Nonmydriatic fundus photograph; 848x848; 45° field of view; camera: NIDEK AFC-230:
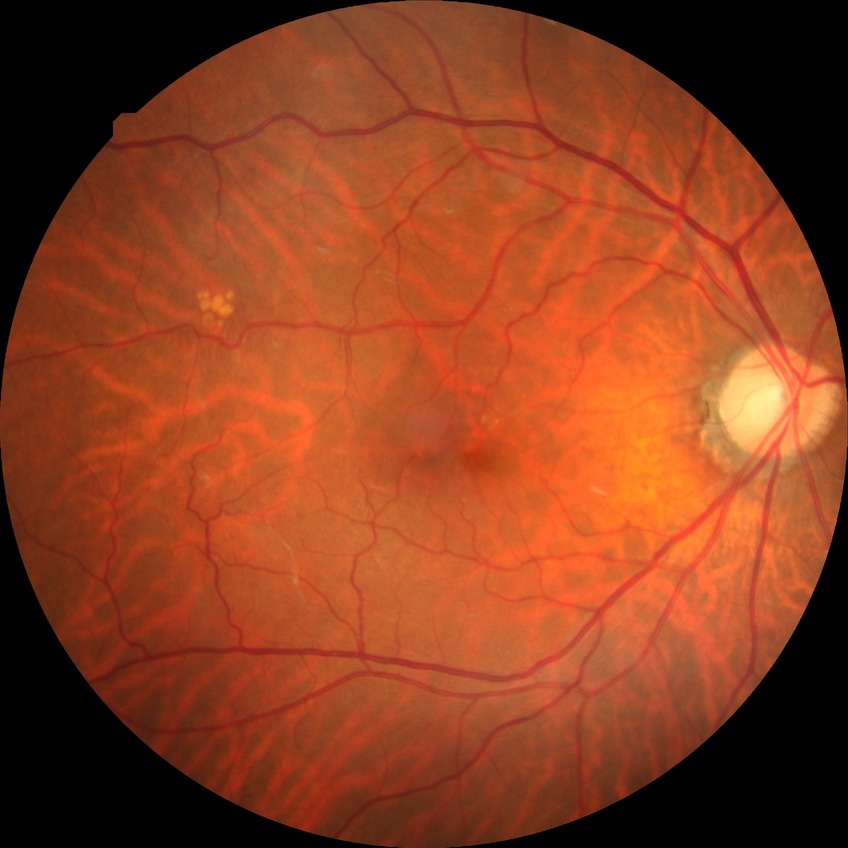

diabetic retinopathy grade = no diabetic retinopathy.